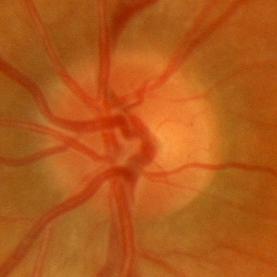
The image shows no glaucomatous optic neuropathy.